45° field of view; 2352 x 1568 pixels; retinal fundus photograph:
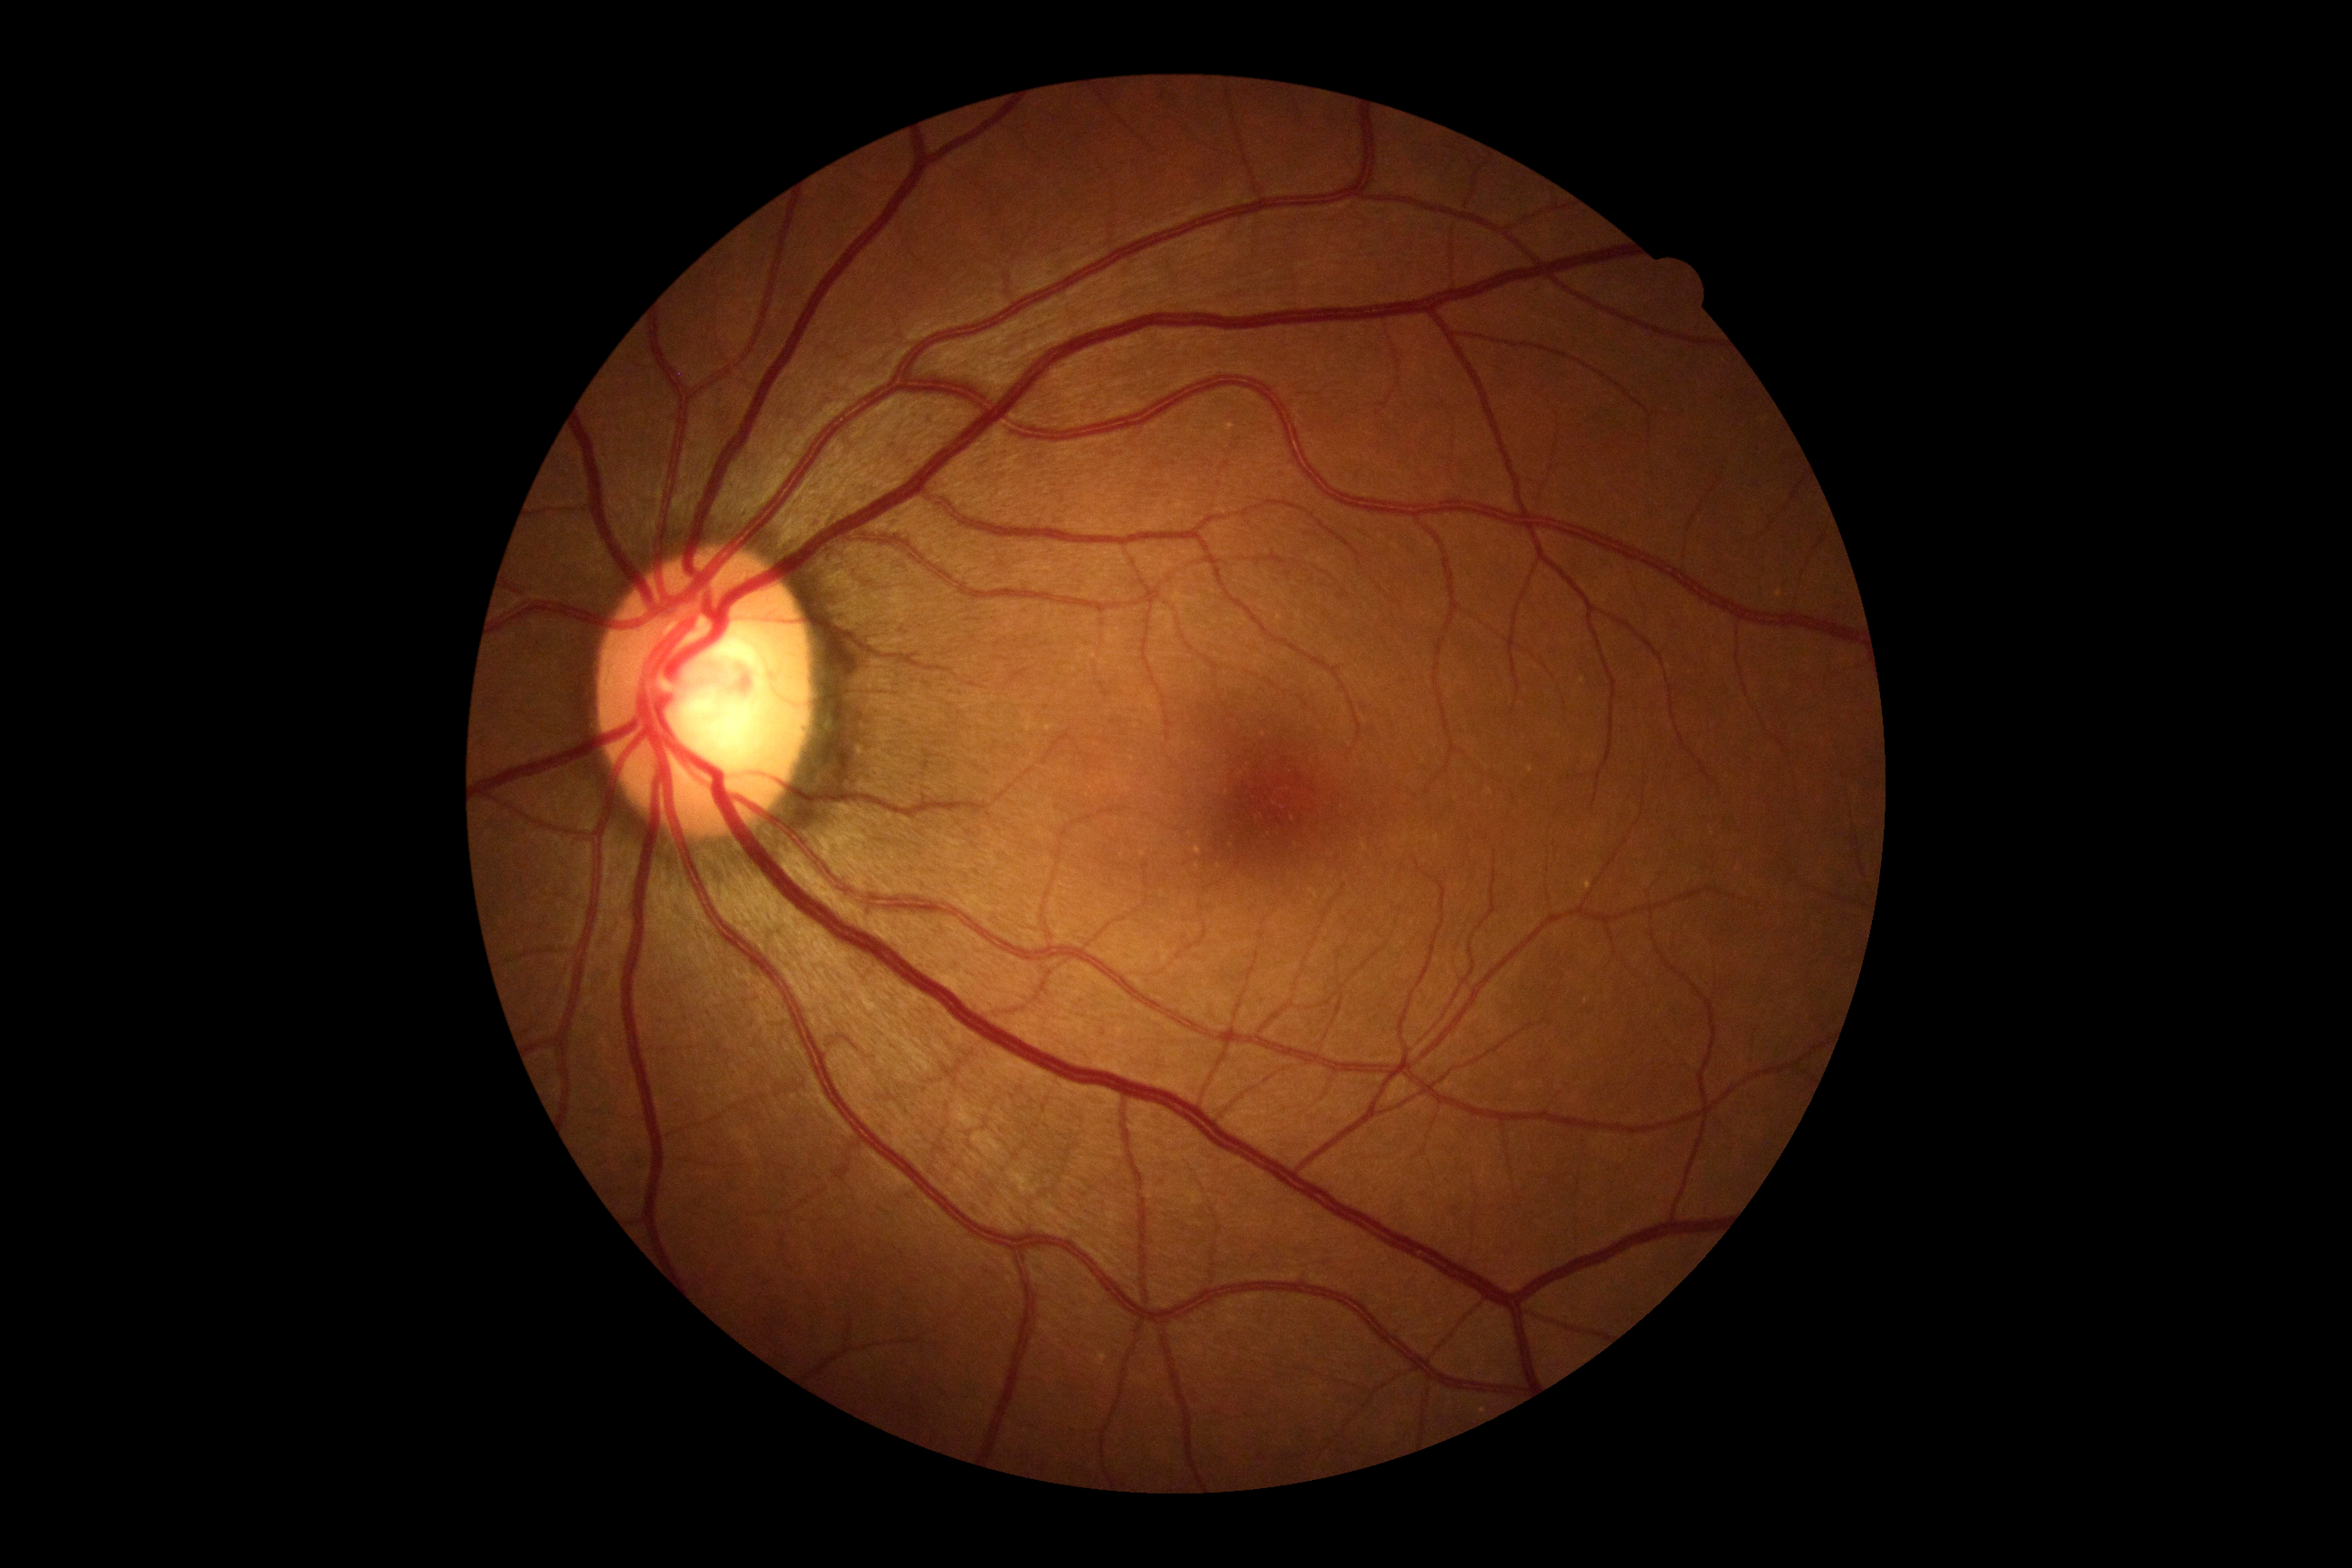 No diabetic retinal disease findings.
DR grade is 0 (no apparent retinopathy).